Captured on a Topcon TRC-NW8 fundus camera
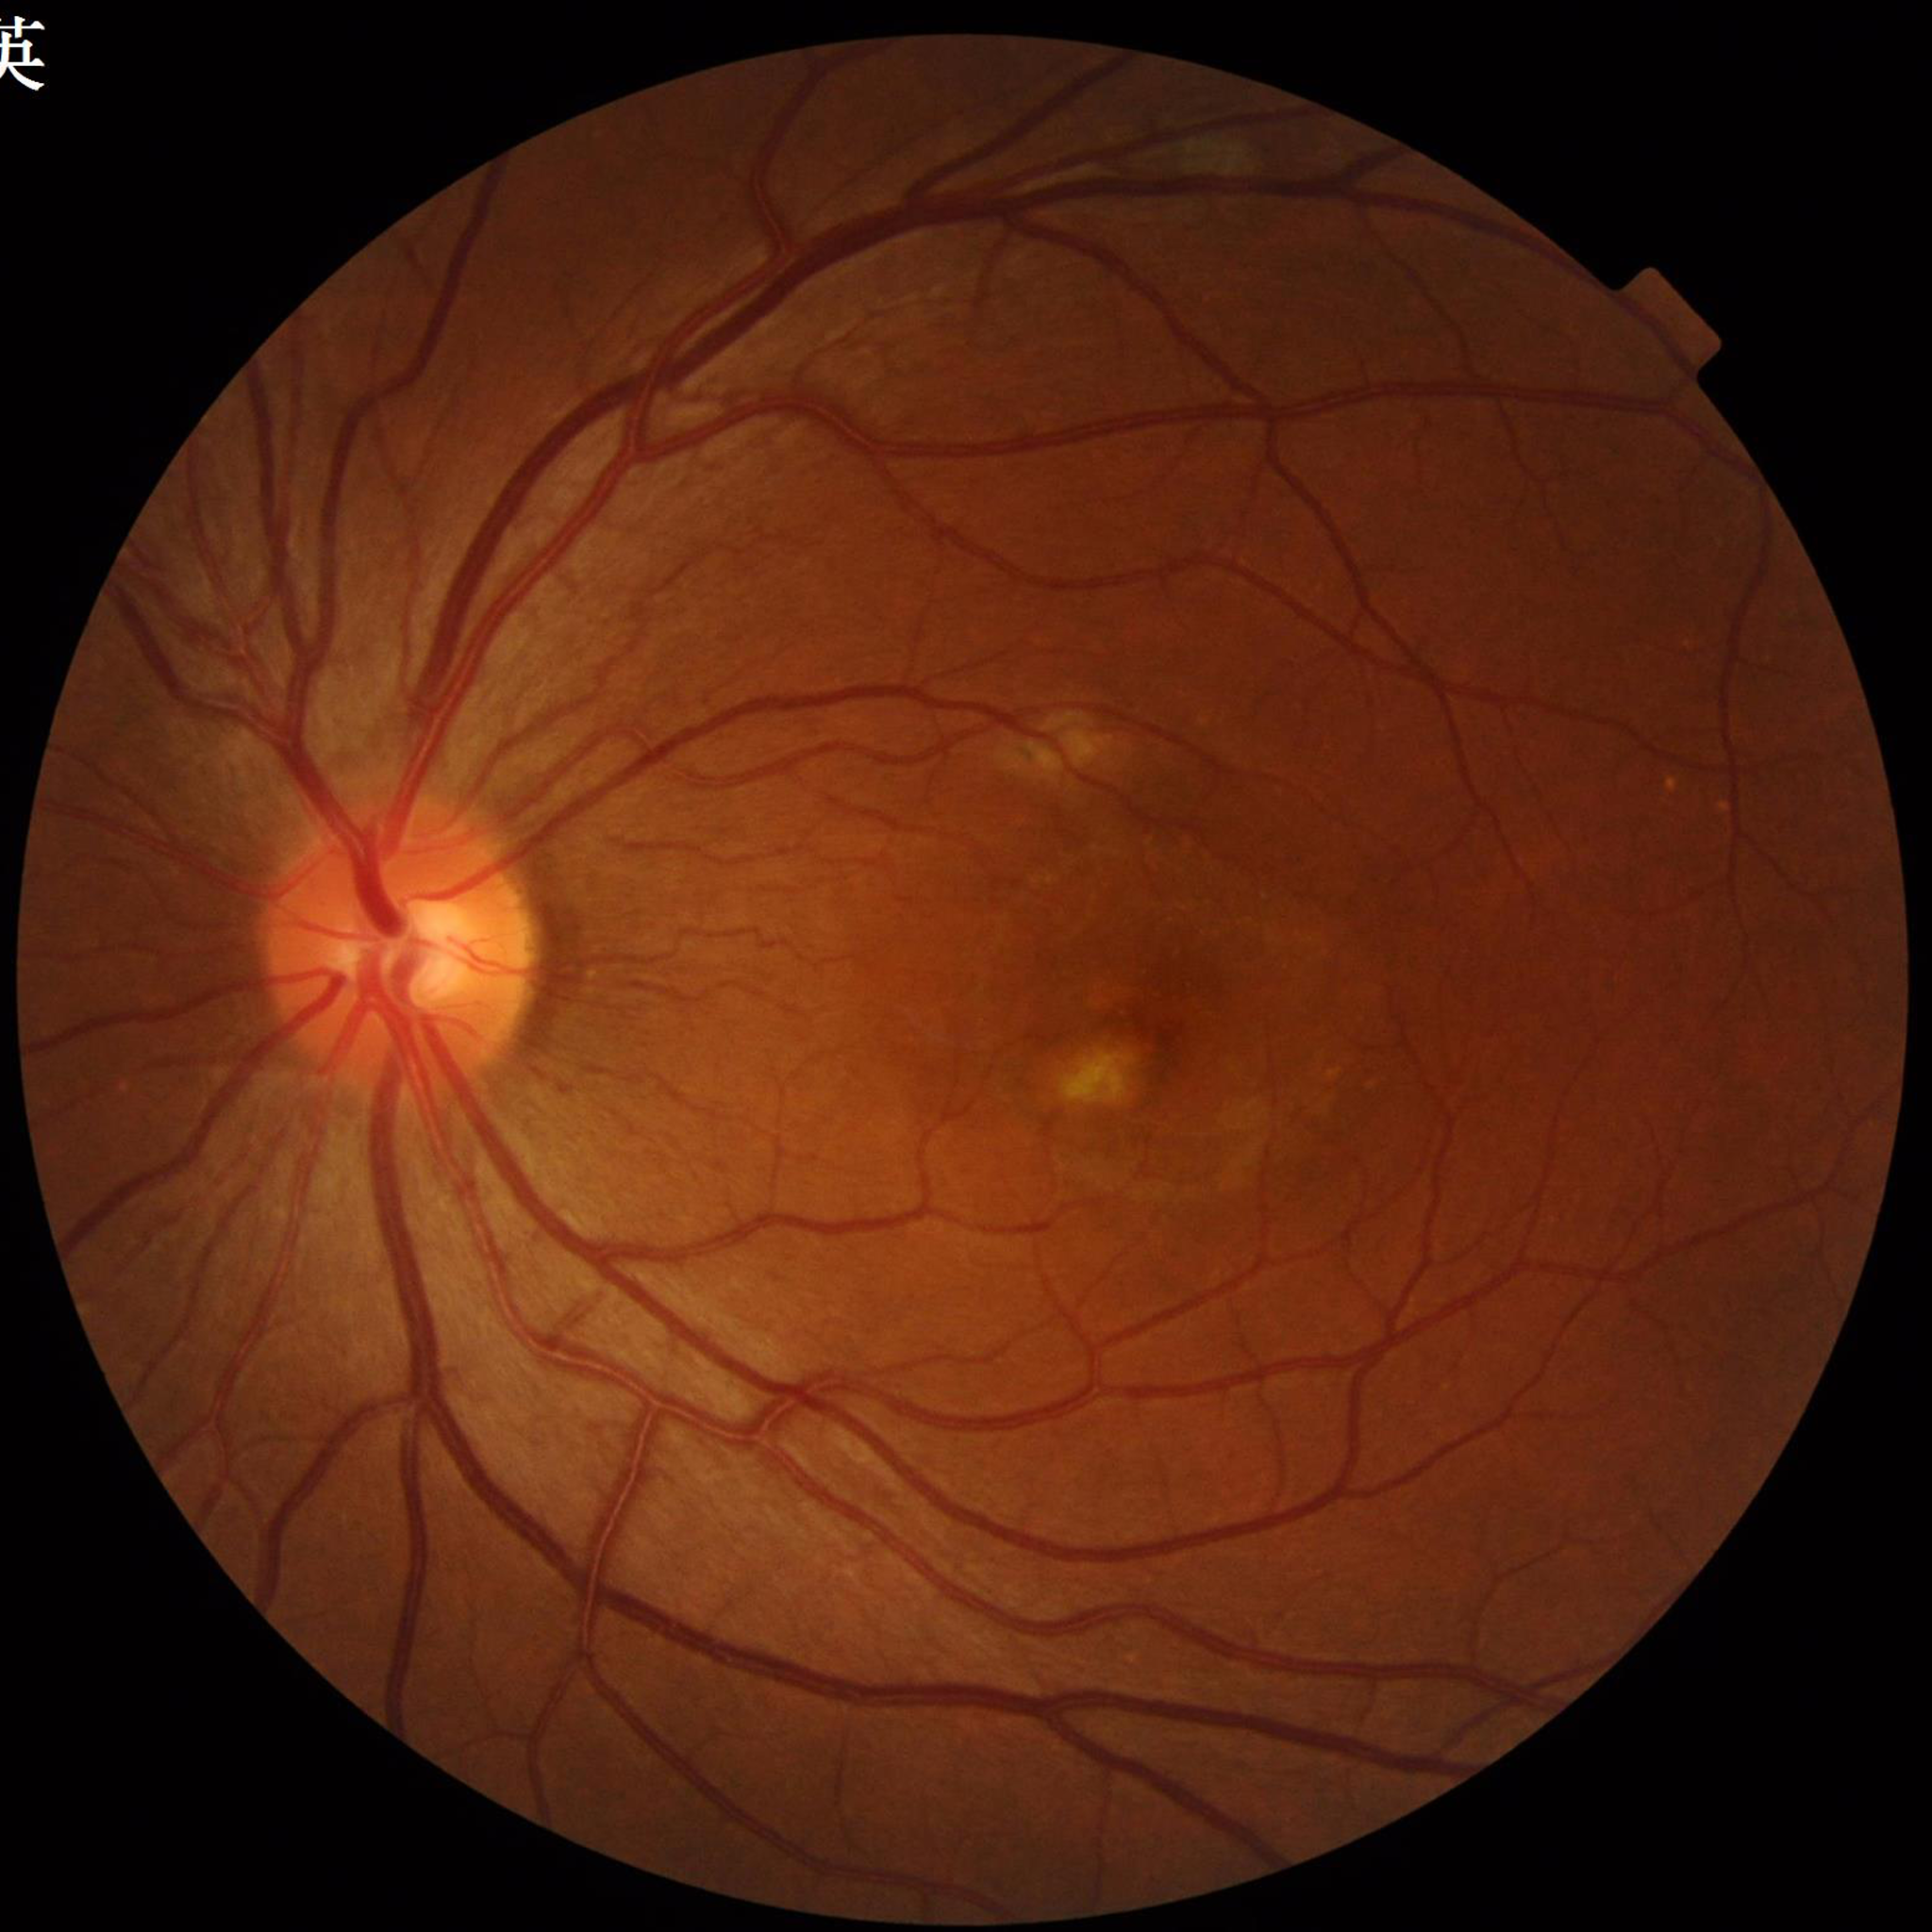 Quality = illumination and color satisfactory, contrast adequate, no blur; Disease class = AMD.